CFP.
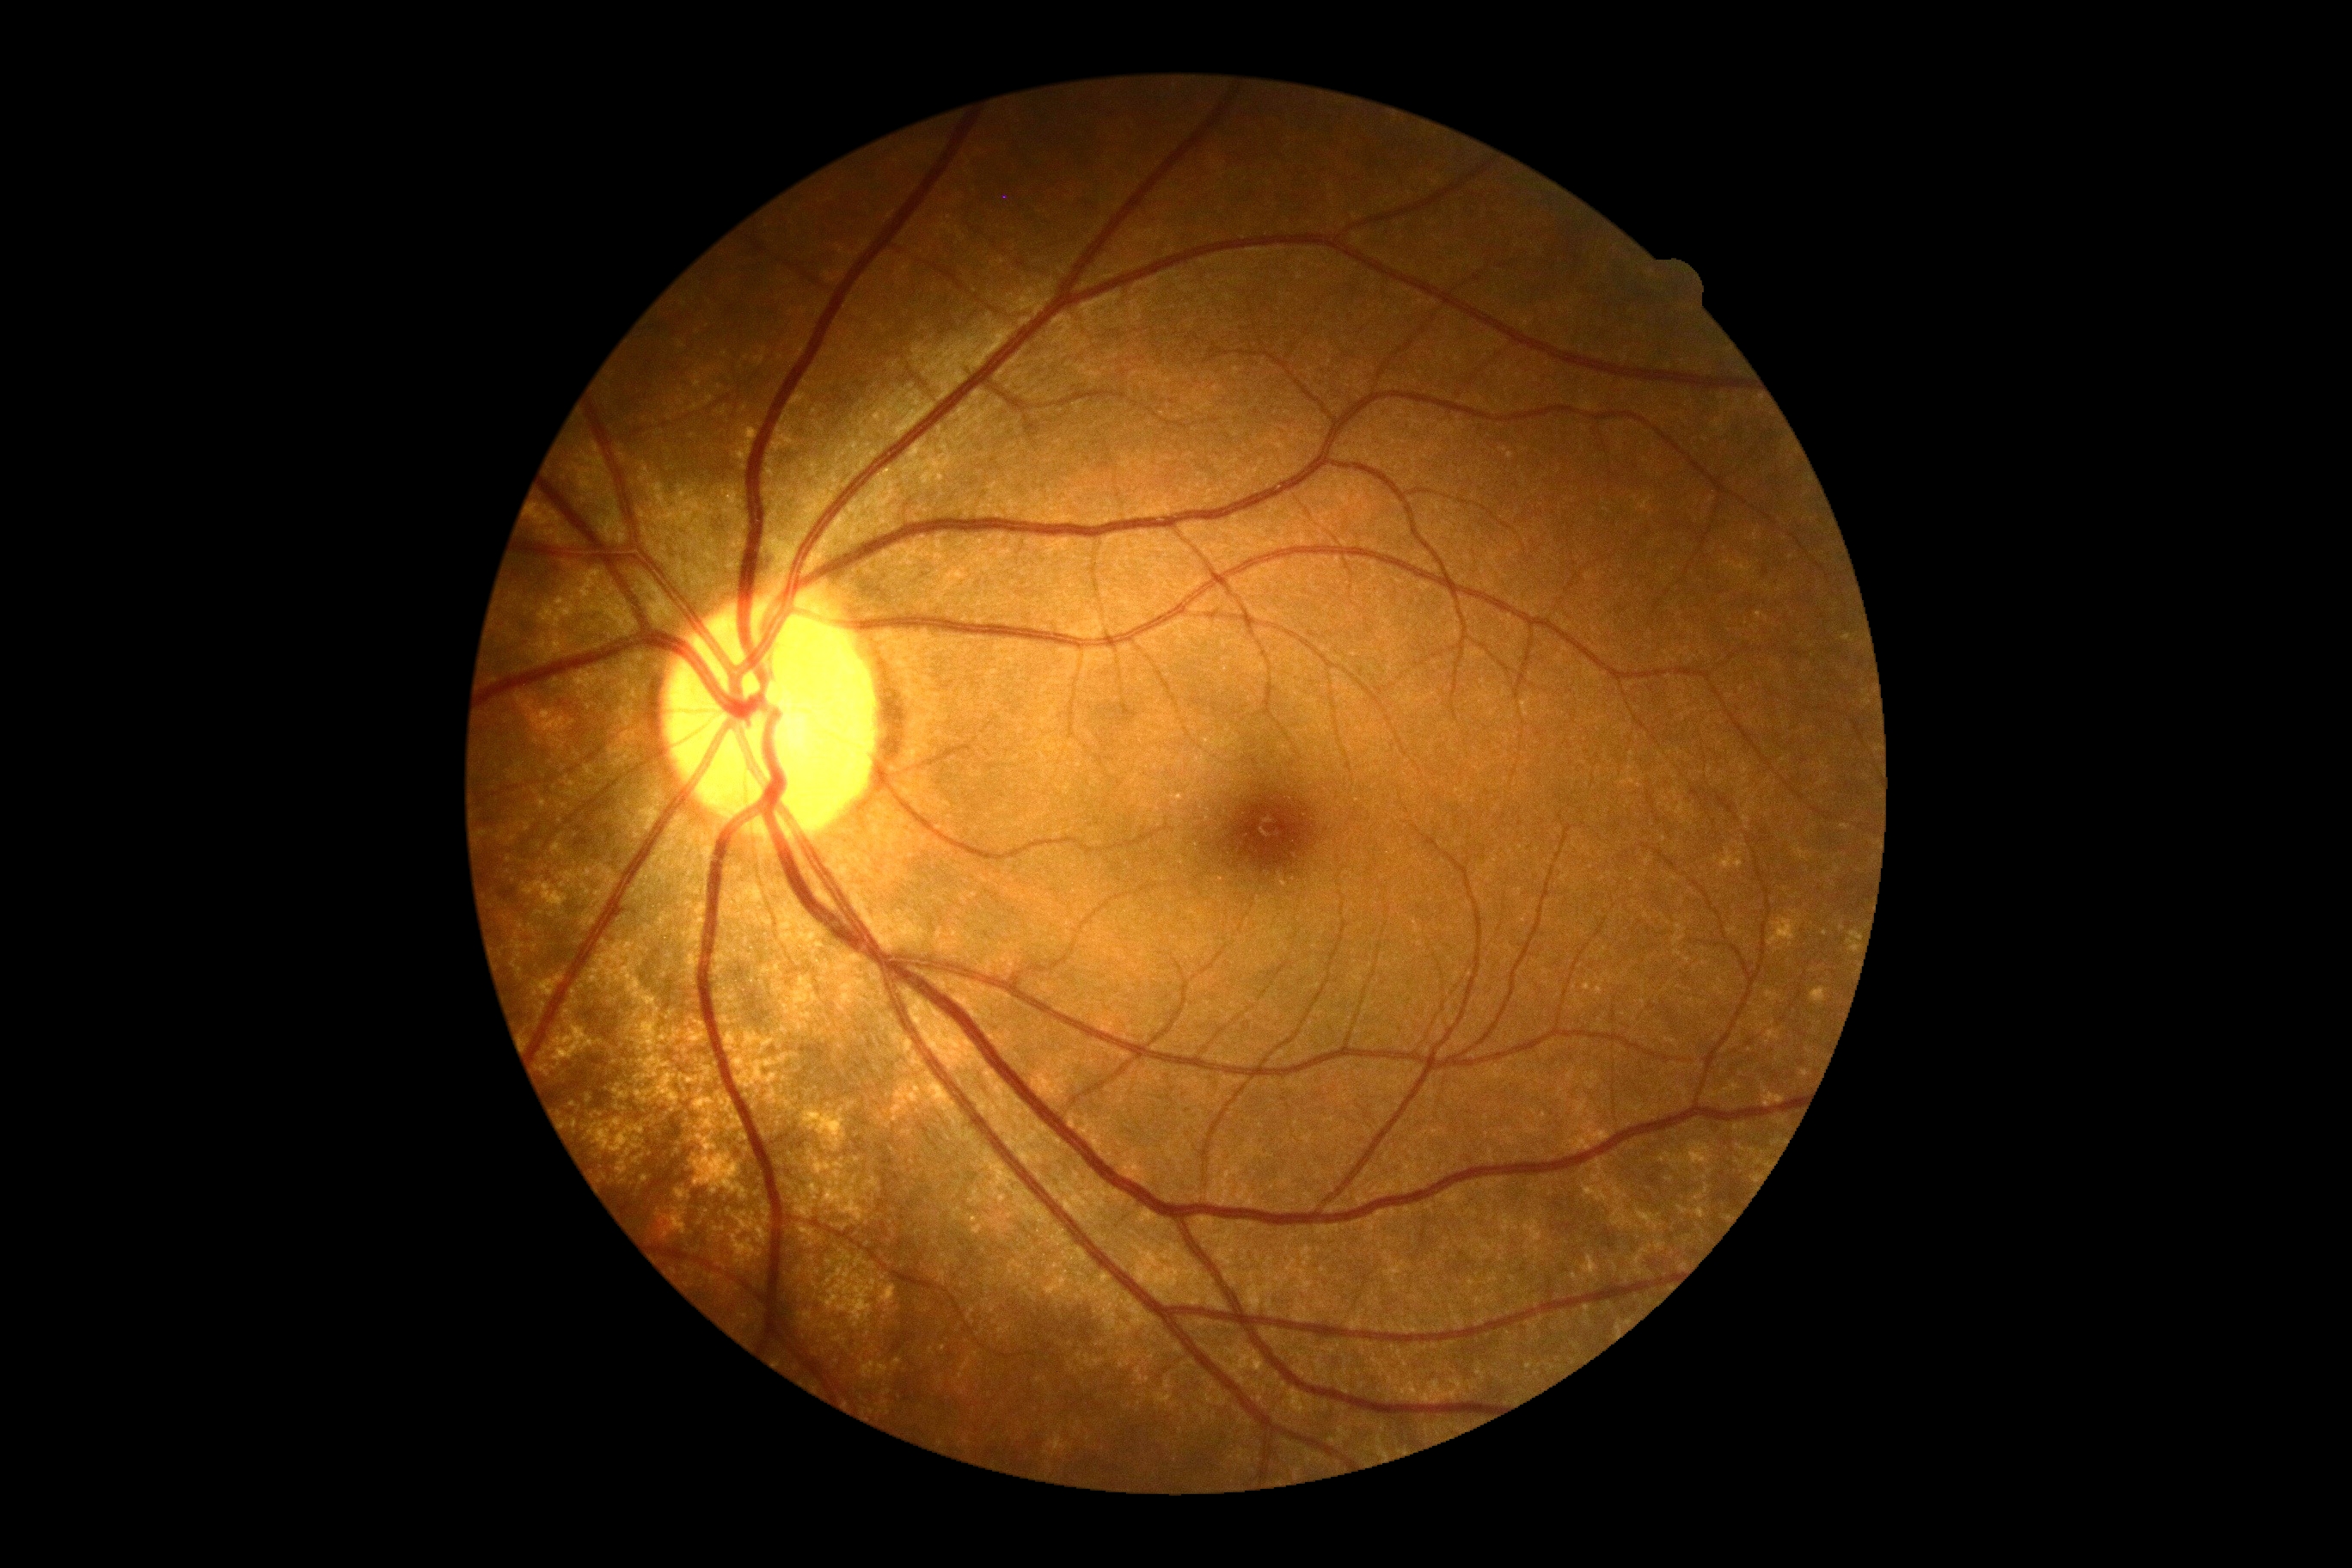 diabetic retinopathy (DR): 0/4 — no visible signs of diabetic retinopathy.